Color fundus photograph, FOV: 45 degrees, 2048 by 1536 pixels
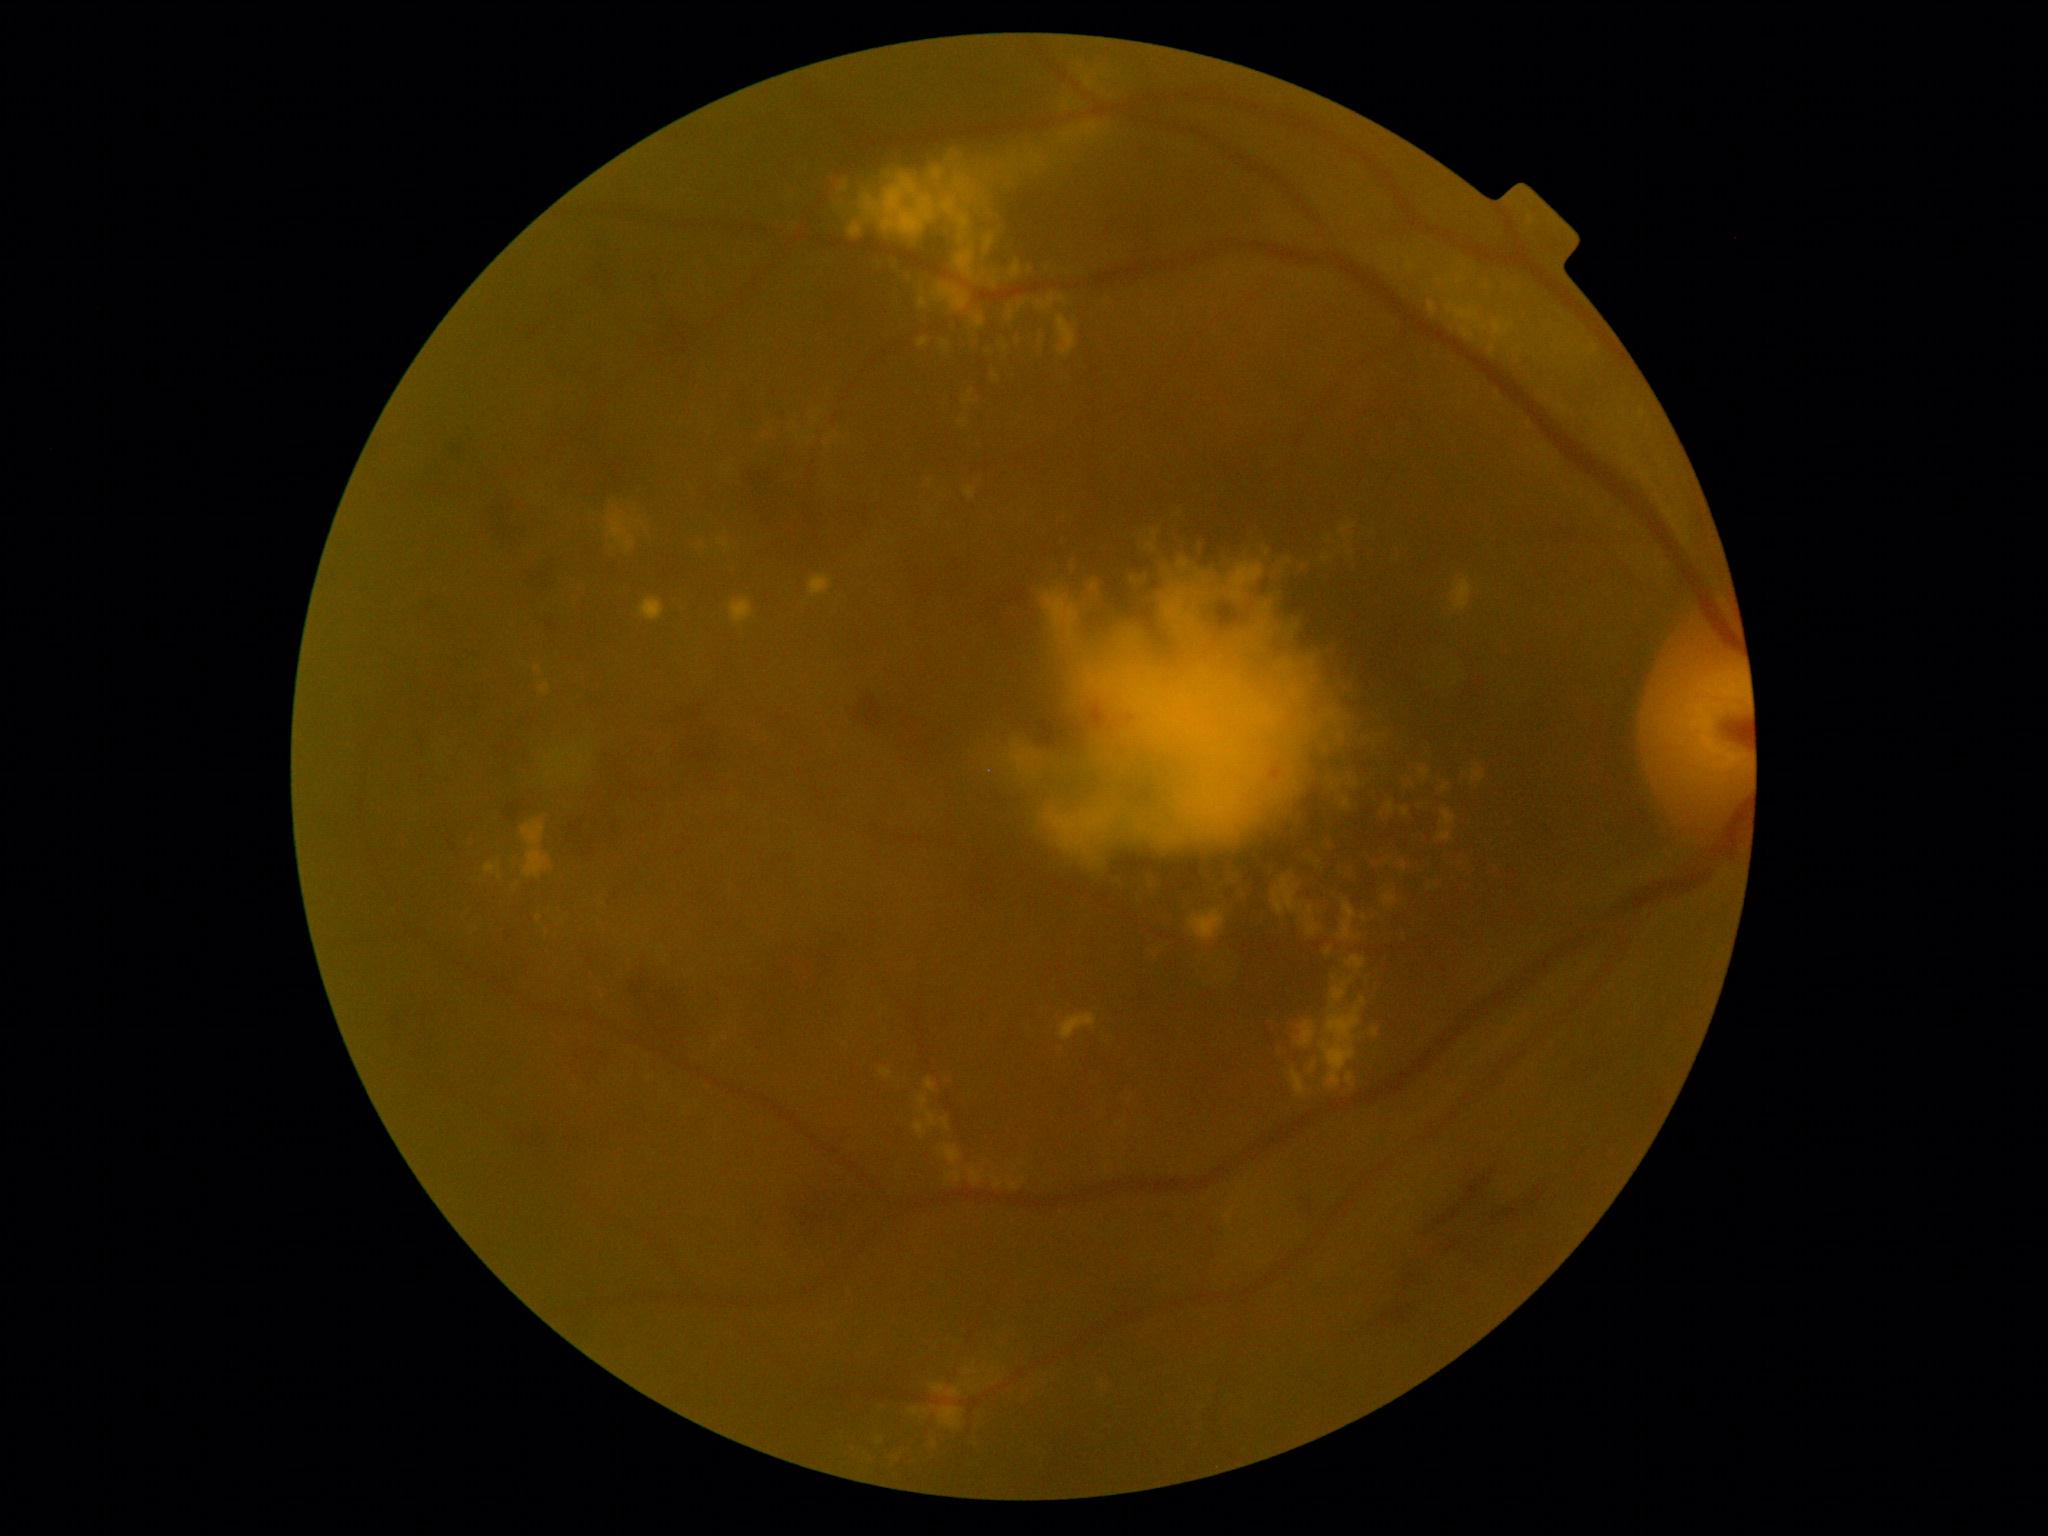
DR grade: 2 (moderate NPDR); non-proliferative diabetic retinopathy
Lesions identified (partial list):
HEs (more not shown): bbox=[425, 465, 444, 483] | bbox=[495, 787, 541, 824] | bbox=[516, 1123, 561, 1153] | bbox=[419, 725, 432, 763] | bbox=[389, 1005, 404, 1047] | bbox=[642, 277, 697, 386] | bbox=[1414, 1161, 1516, 1236] | bbox=[1030, 704, 1067, 747] | bbox=[741, 443, 871, 568] | bbox=[1397, 1257, 1433, 1289] | bbox=[1450, 1161, 1561, 1259] | bbox=[489, 486, 528, 553] | bbox=[531, 291, 569, 341] | bbox=[1348, 1298, 1424, 1341] | bbox=[587, 229, 618, 297]
EXs (more not shown): bbox=[1452, 578, 1473, 611] | bbox=[1347, 1072, 1354, 1084] | bbox=[942, 1118, 951, 1131] | bbox=[1315, 896, 1327, 926] | bbox=[1305, 850, 1324, 875] | bbox=[1447, 302, 1480, 338] | bbox=[1269, 873, 1308, 895] | bbox=[1221, 860, 1246, 883] | bbox=[1010, 260, 1023, 280] | bbox=[1137, 543, 1152, 553] | bbox=[922, 1409, 929, 1417] | bbox=[1401, 777, 1417, 790] | bbox=[892, 261, 935, 294] | bbox=[861, 166, 980, 257] | bbox=[929, 480, 932, 488] | bbox=[1028, 152, 1047, 169] | bbox=[929, 1384, 946, 1394]
Small EXs near {"x": 1446, "y": 787}